Pediatric wide-field fundus photograph.
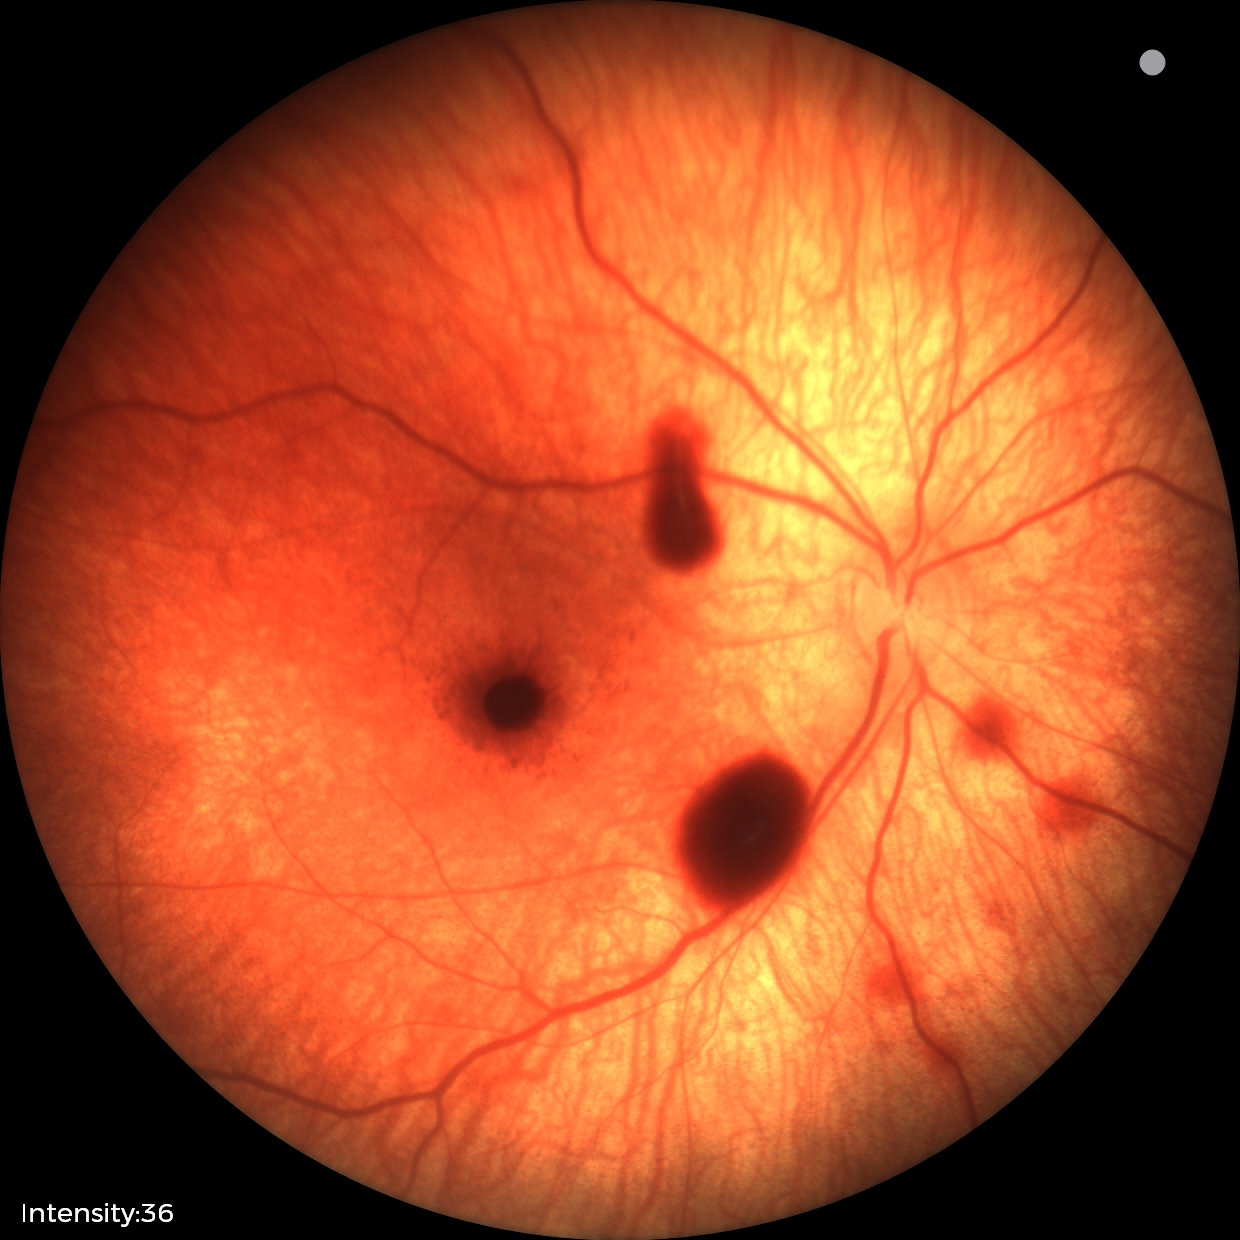
Diagnosis from this screening exam: retinal hemorrhages.